Wide-field fundus image from infant ROP screening — 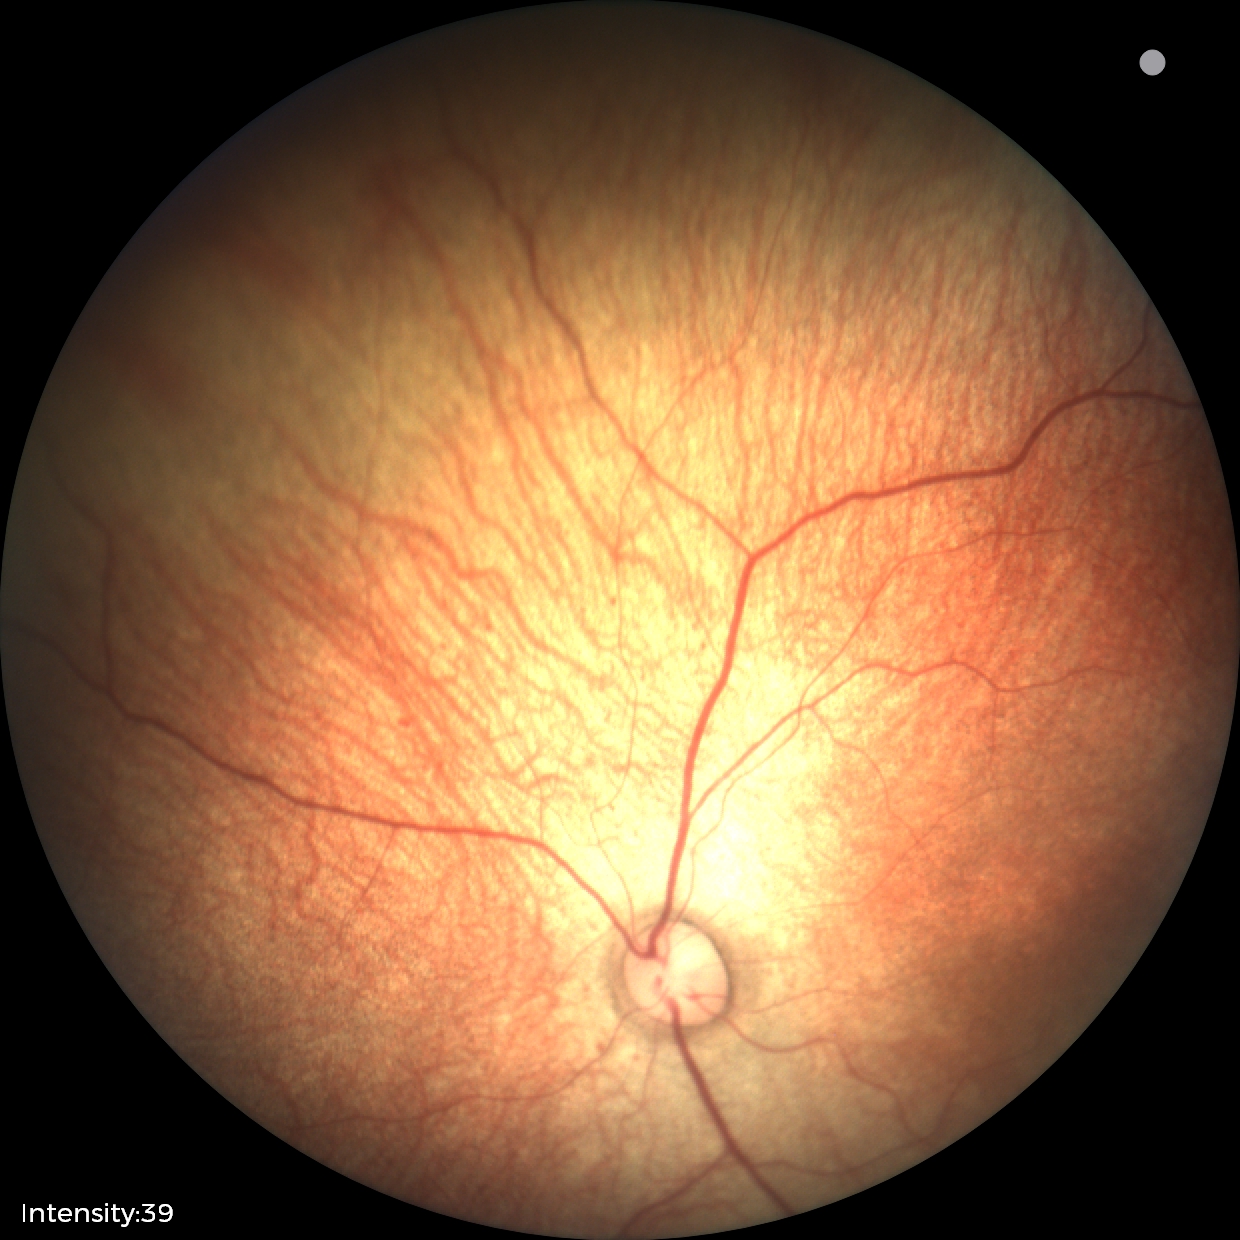

No retinal pathology identified on screening.